DR severity per modified Davis staging:
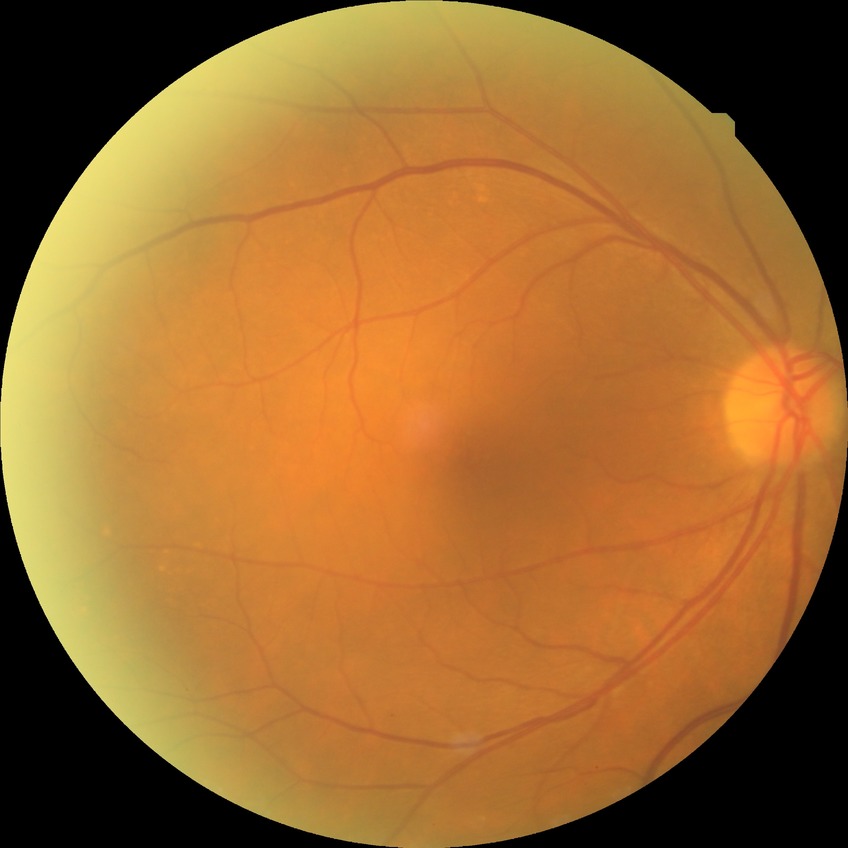
Modified Davis classification is no diabetic retinopathy.